NIDEK AFC-230 fundus camera
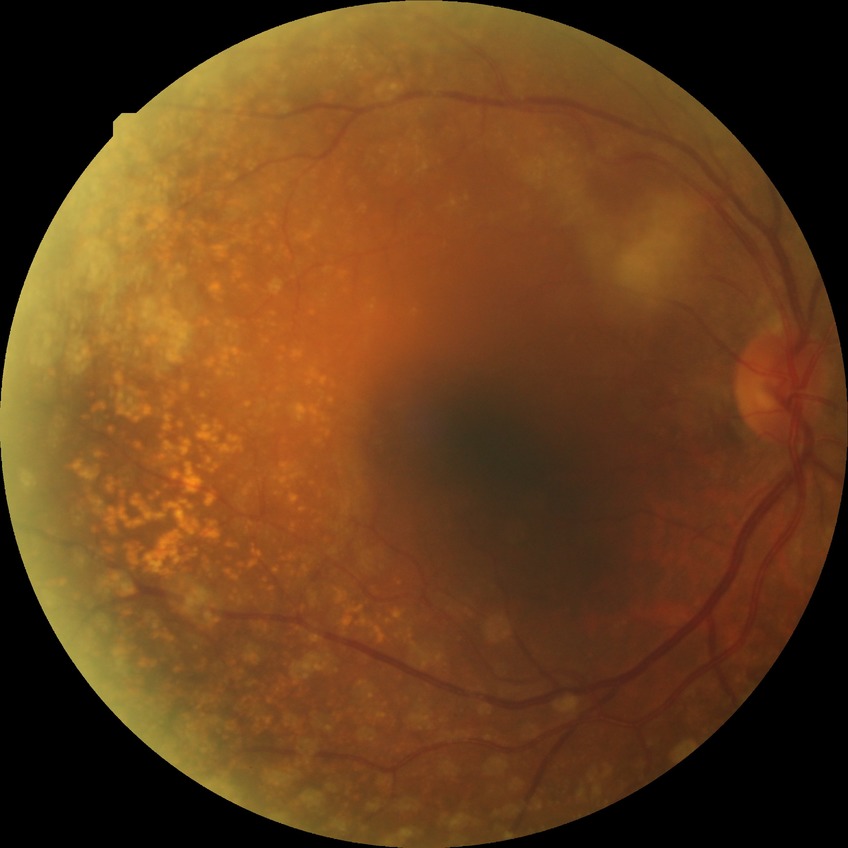

diabetic retinopathy (DR): no diabetic retinopathy (NDR).